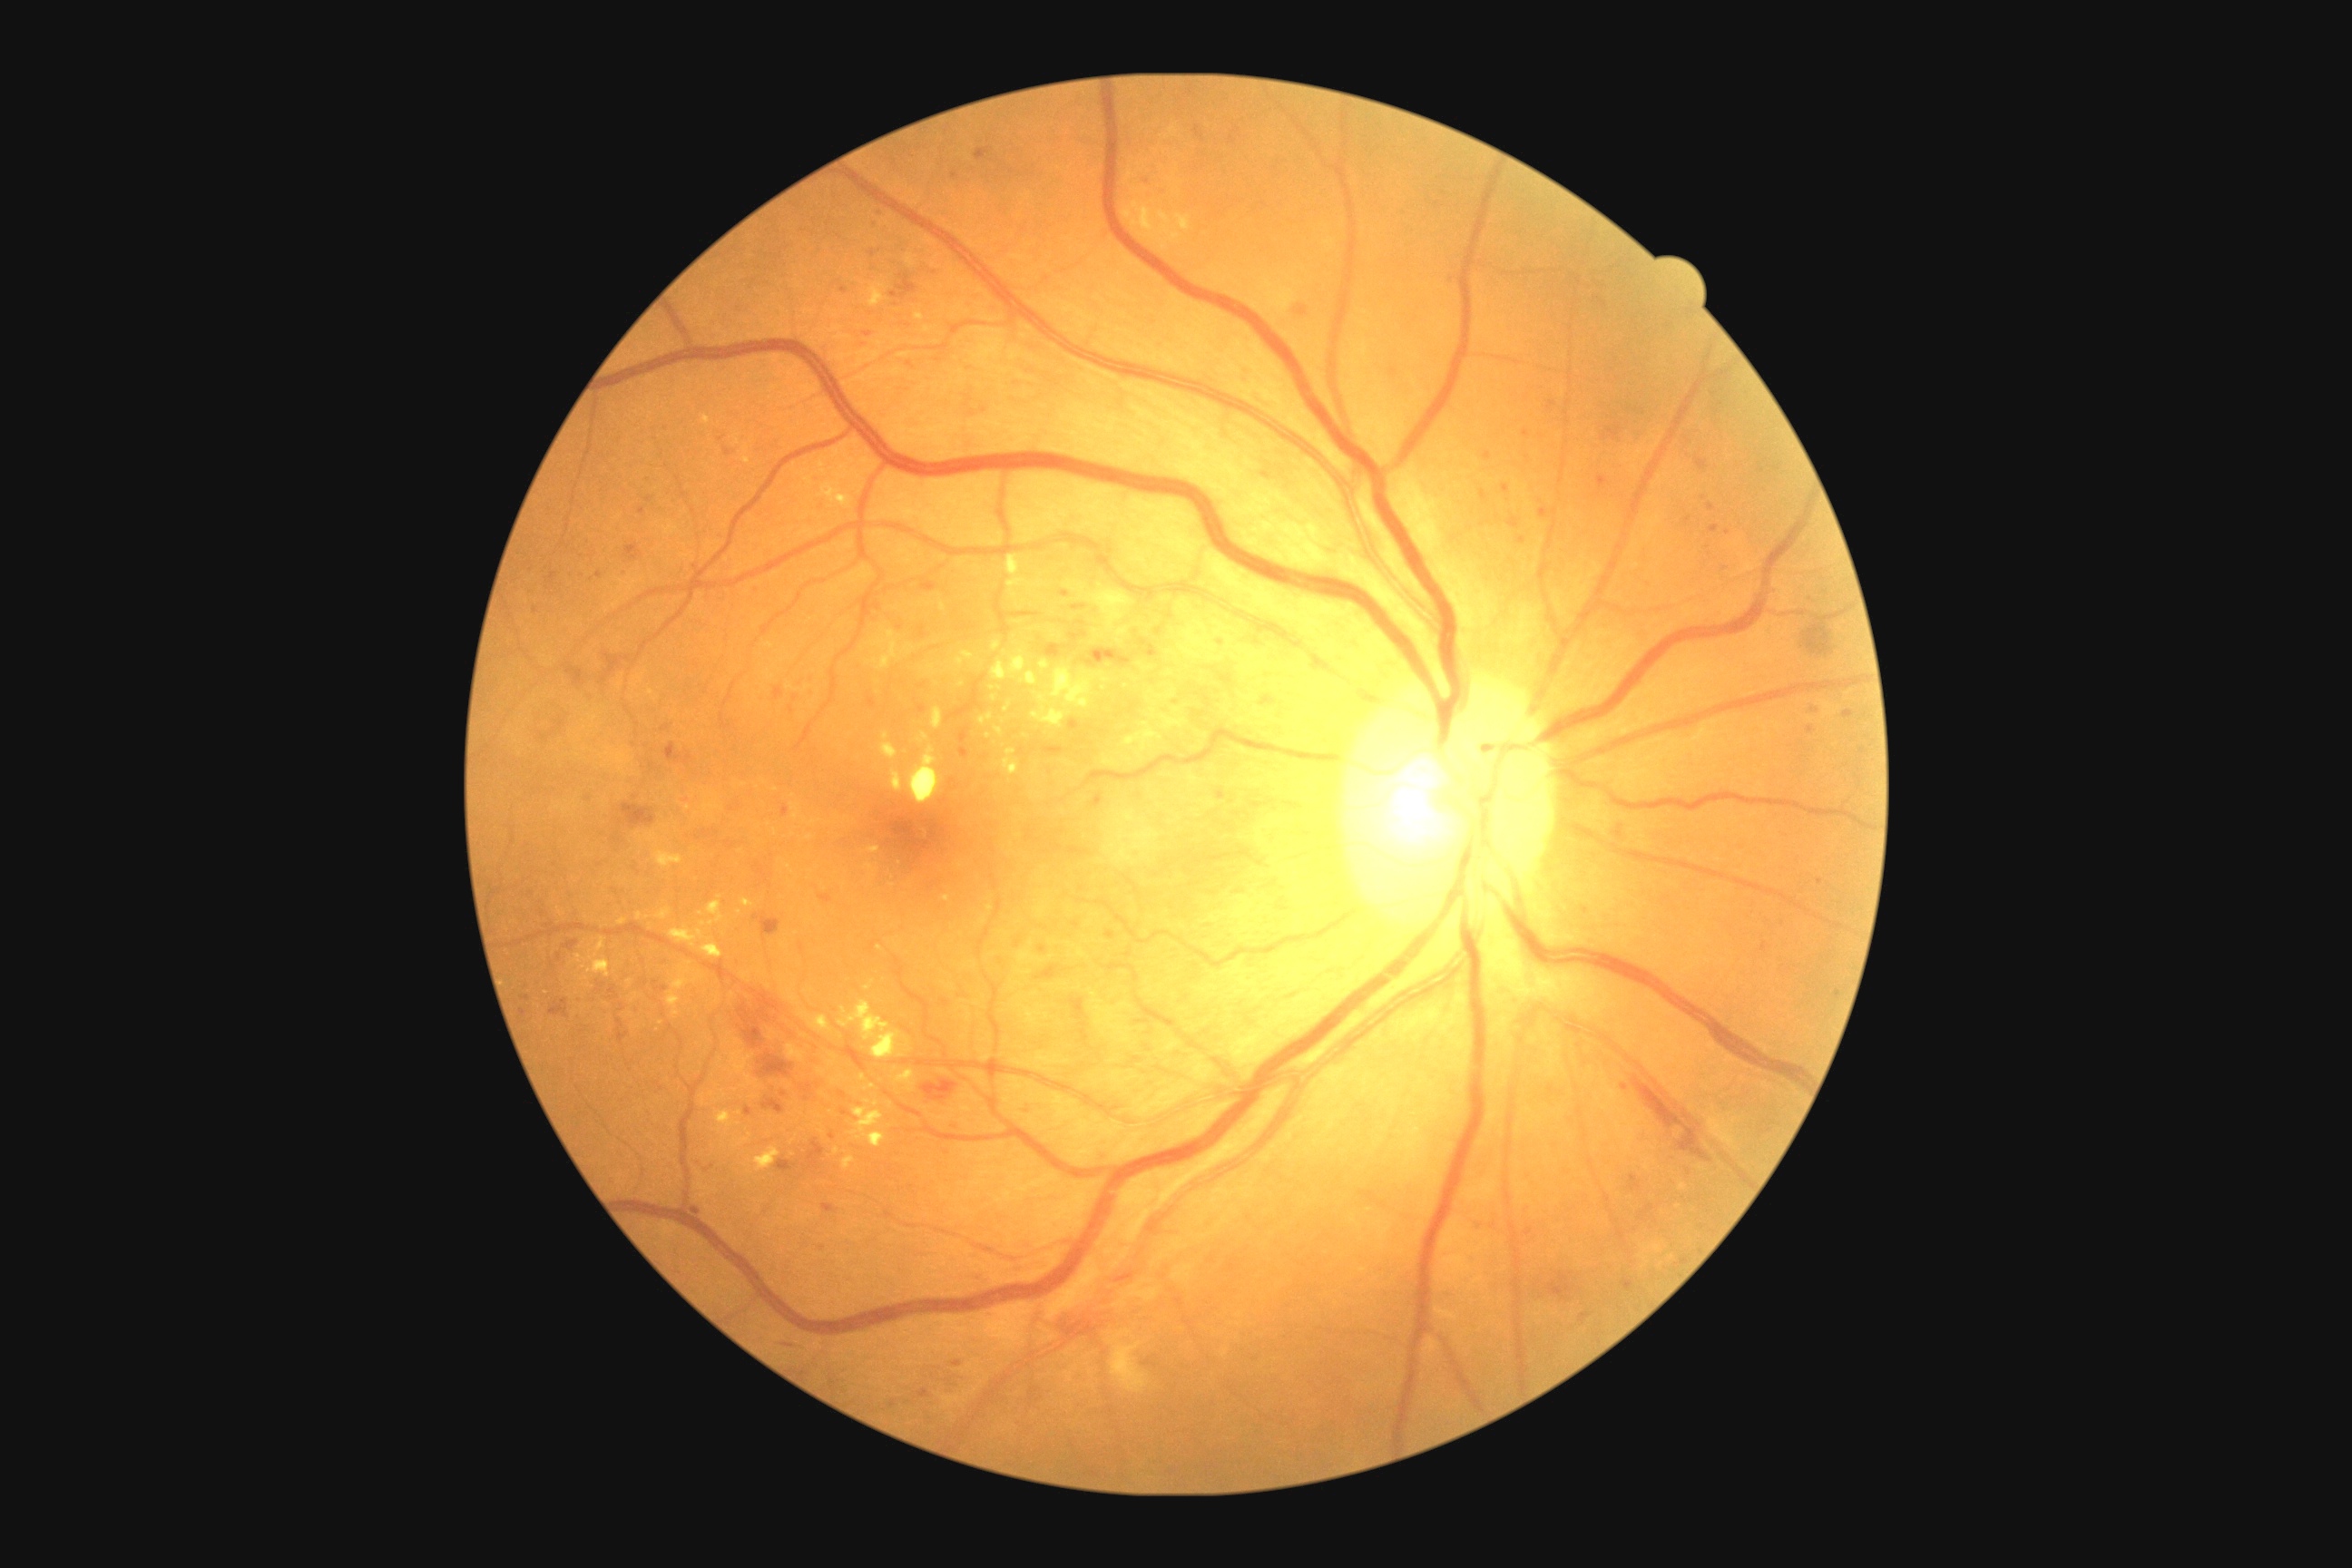

Disease class: non-proliferative diabetic retinopathy. Diabetic retinopathy grade is 2/4.